Retinal fundus photograph; 45° field of view.
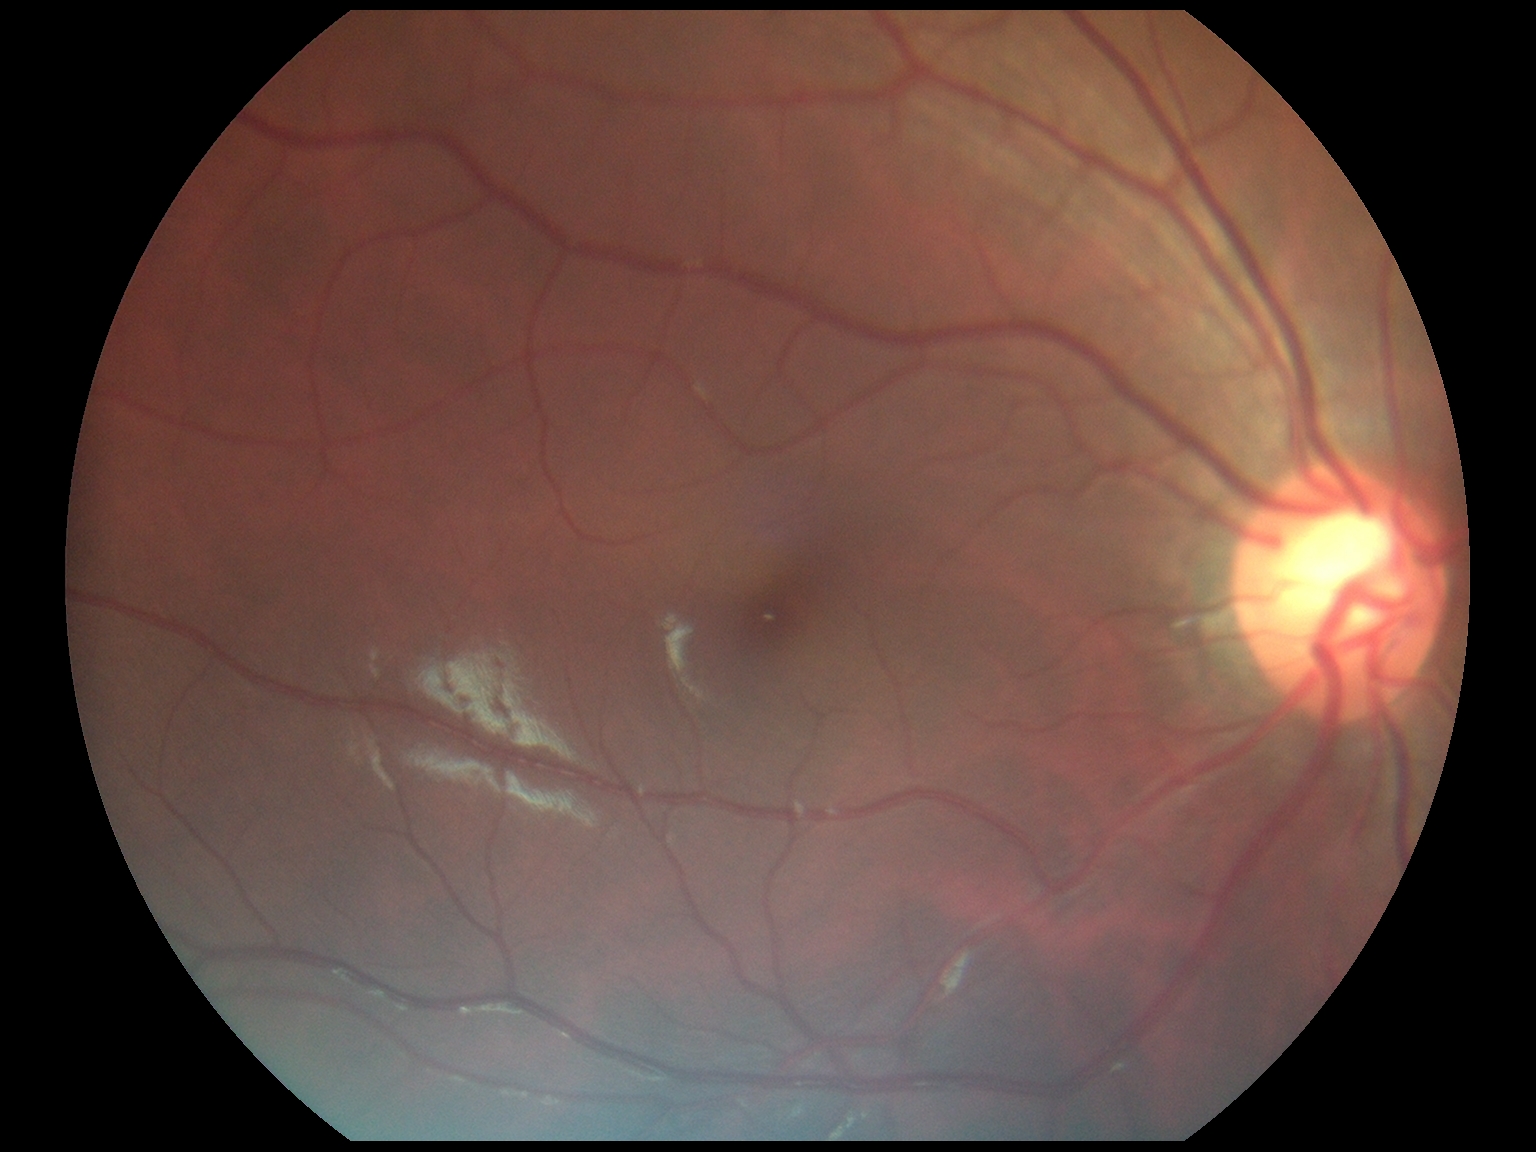 DR is grade 0 (no apparent retinopathy).